Wide-field contact fundus photograph of an infant
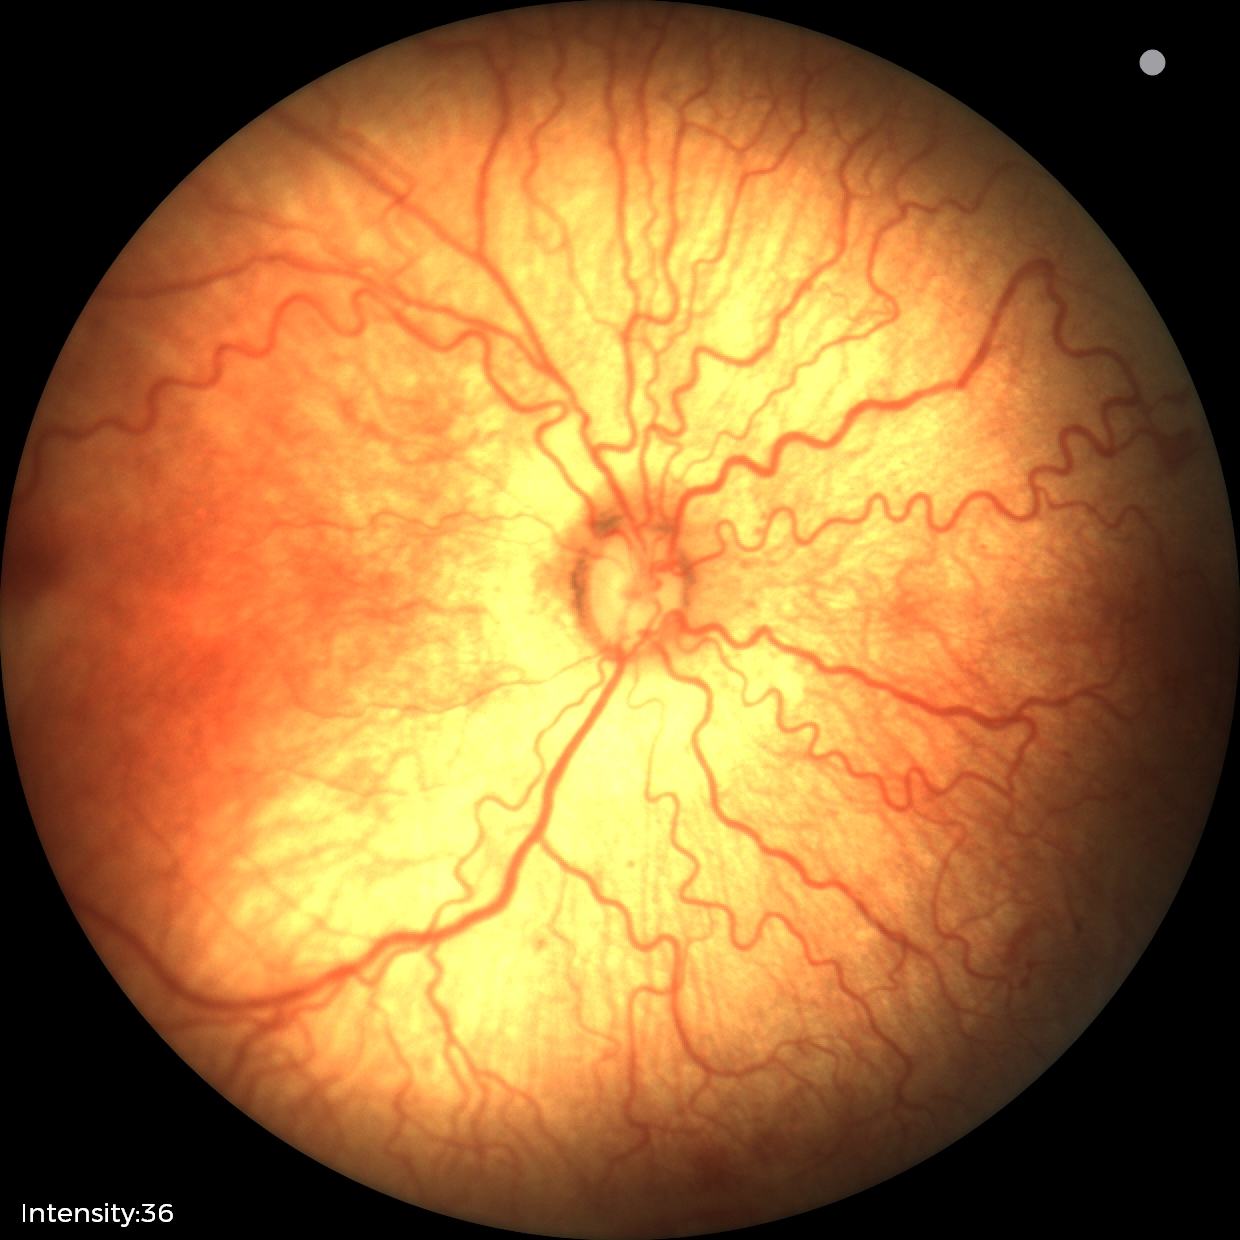

ROP stage: 2.